1240x1240; pediatric retinal photograph (wide-field): 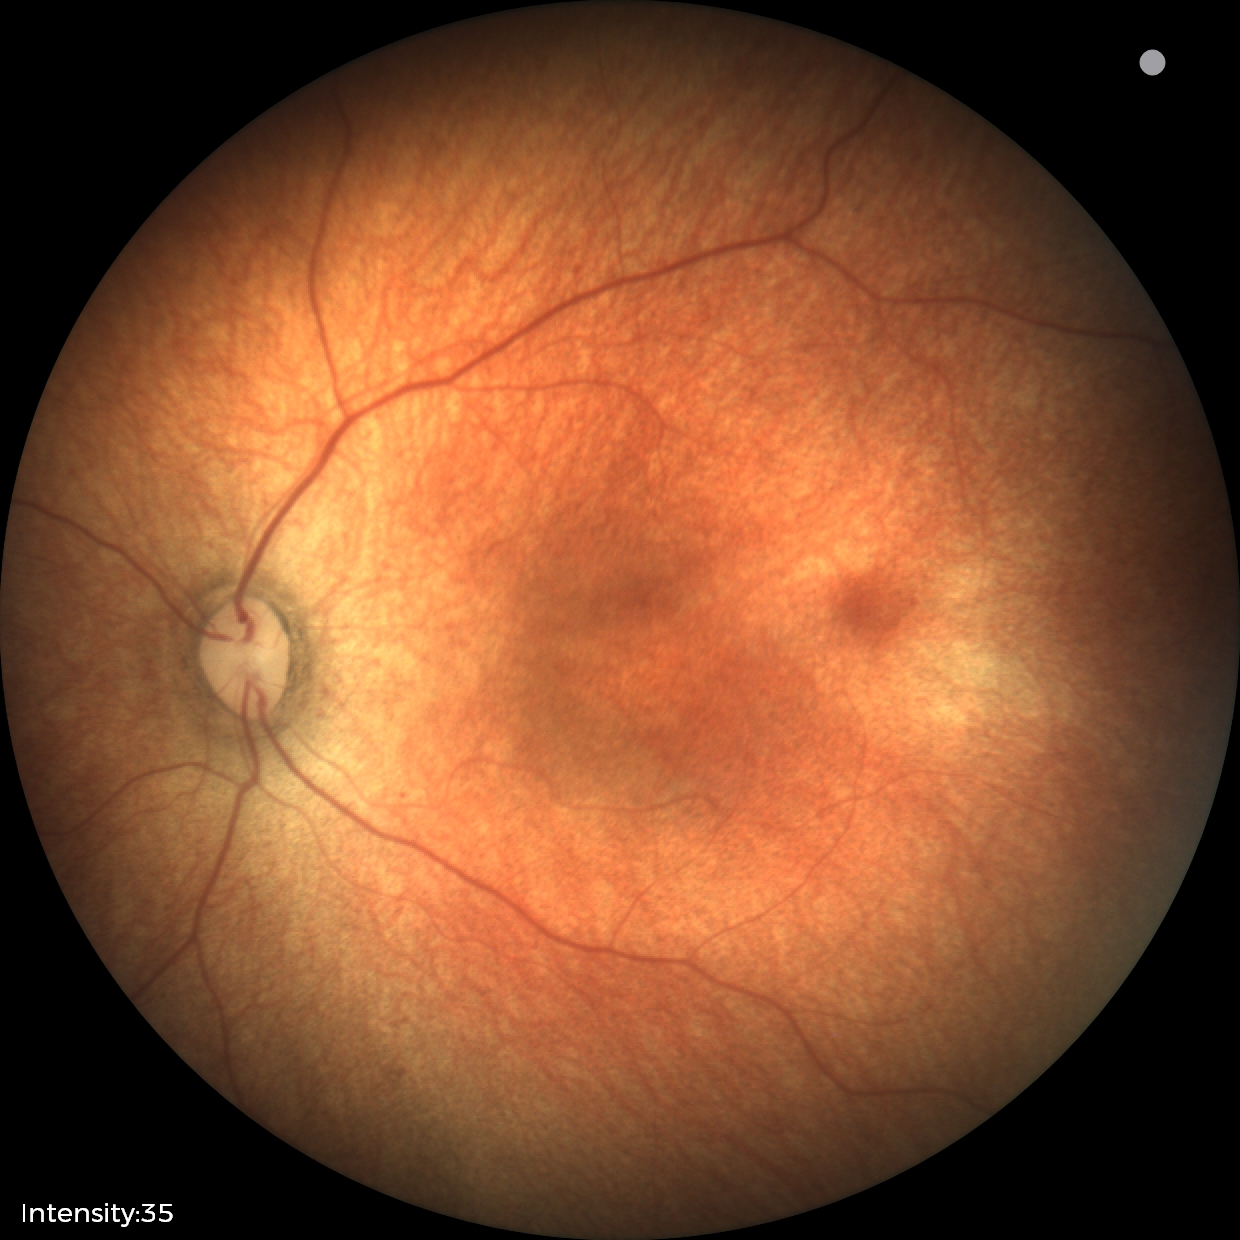
Impression: normal retinal appearance.